Retinal fundus photograph.
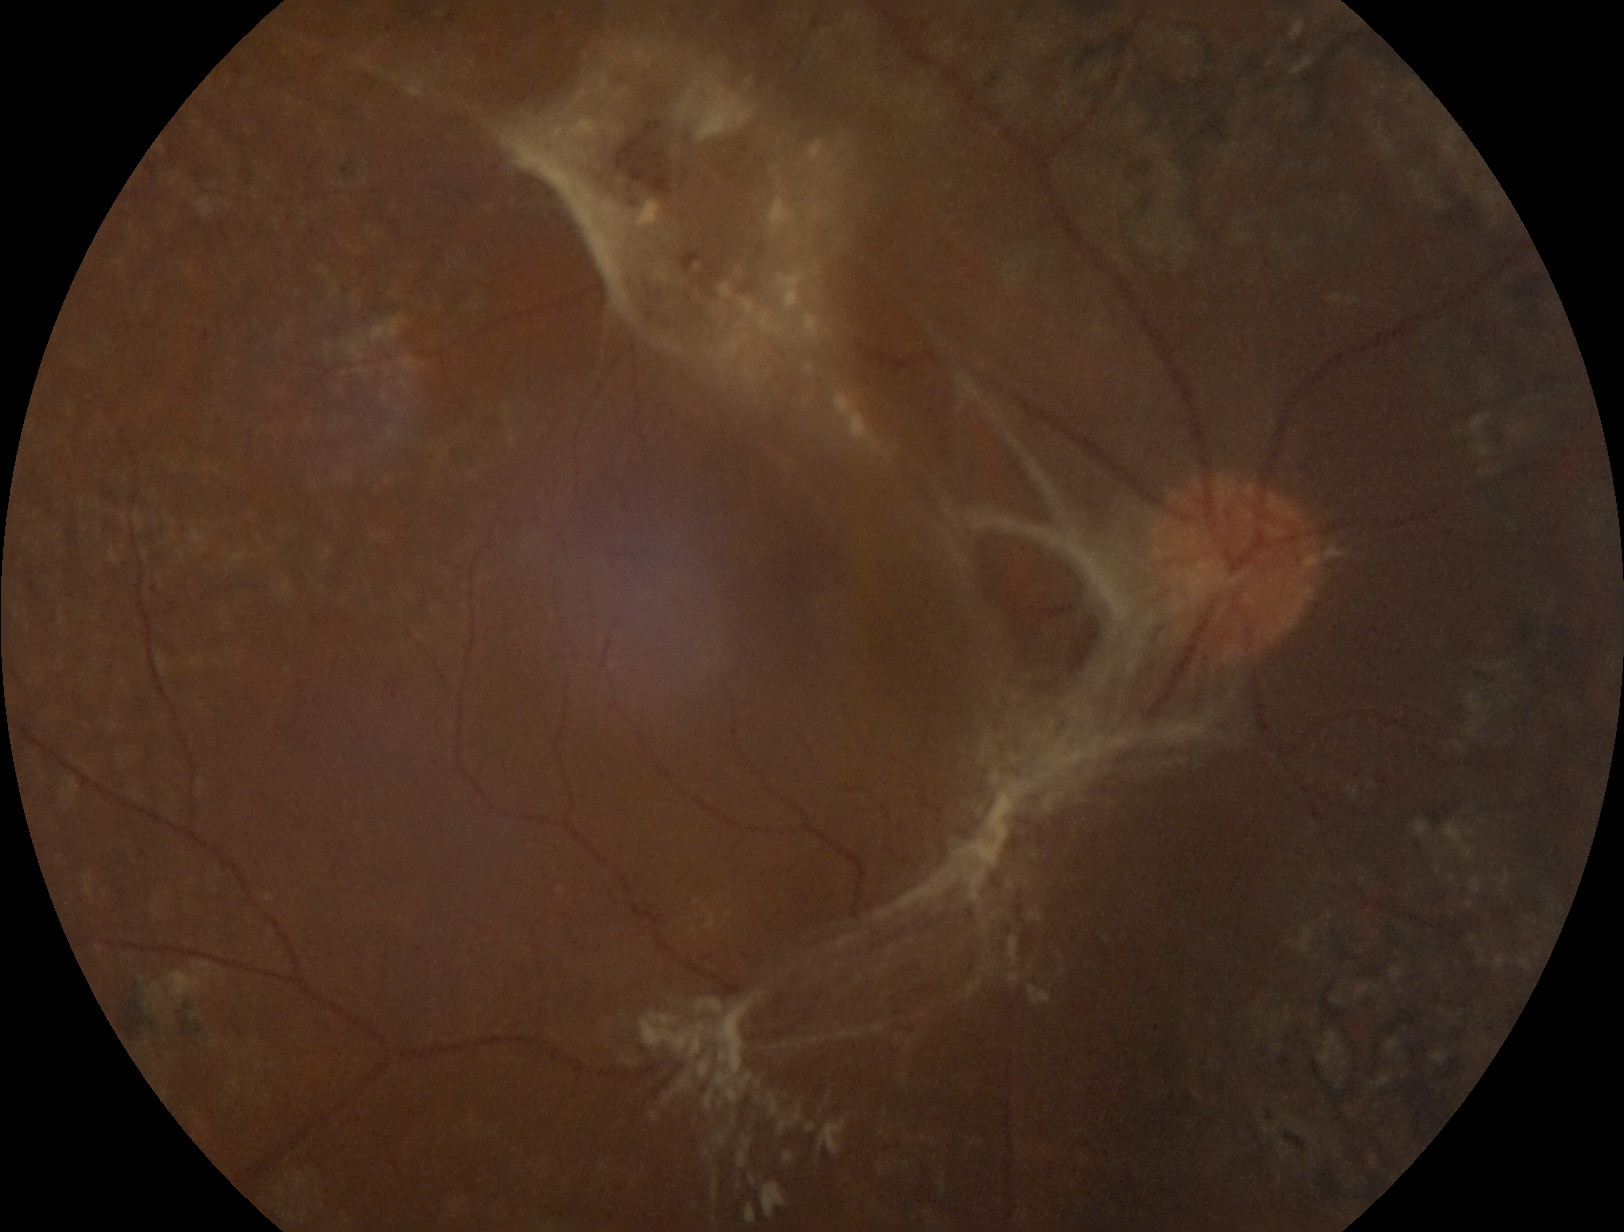
dr_grade: 4